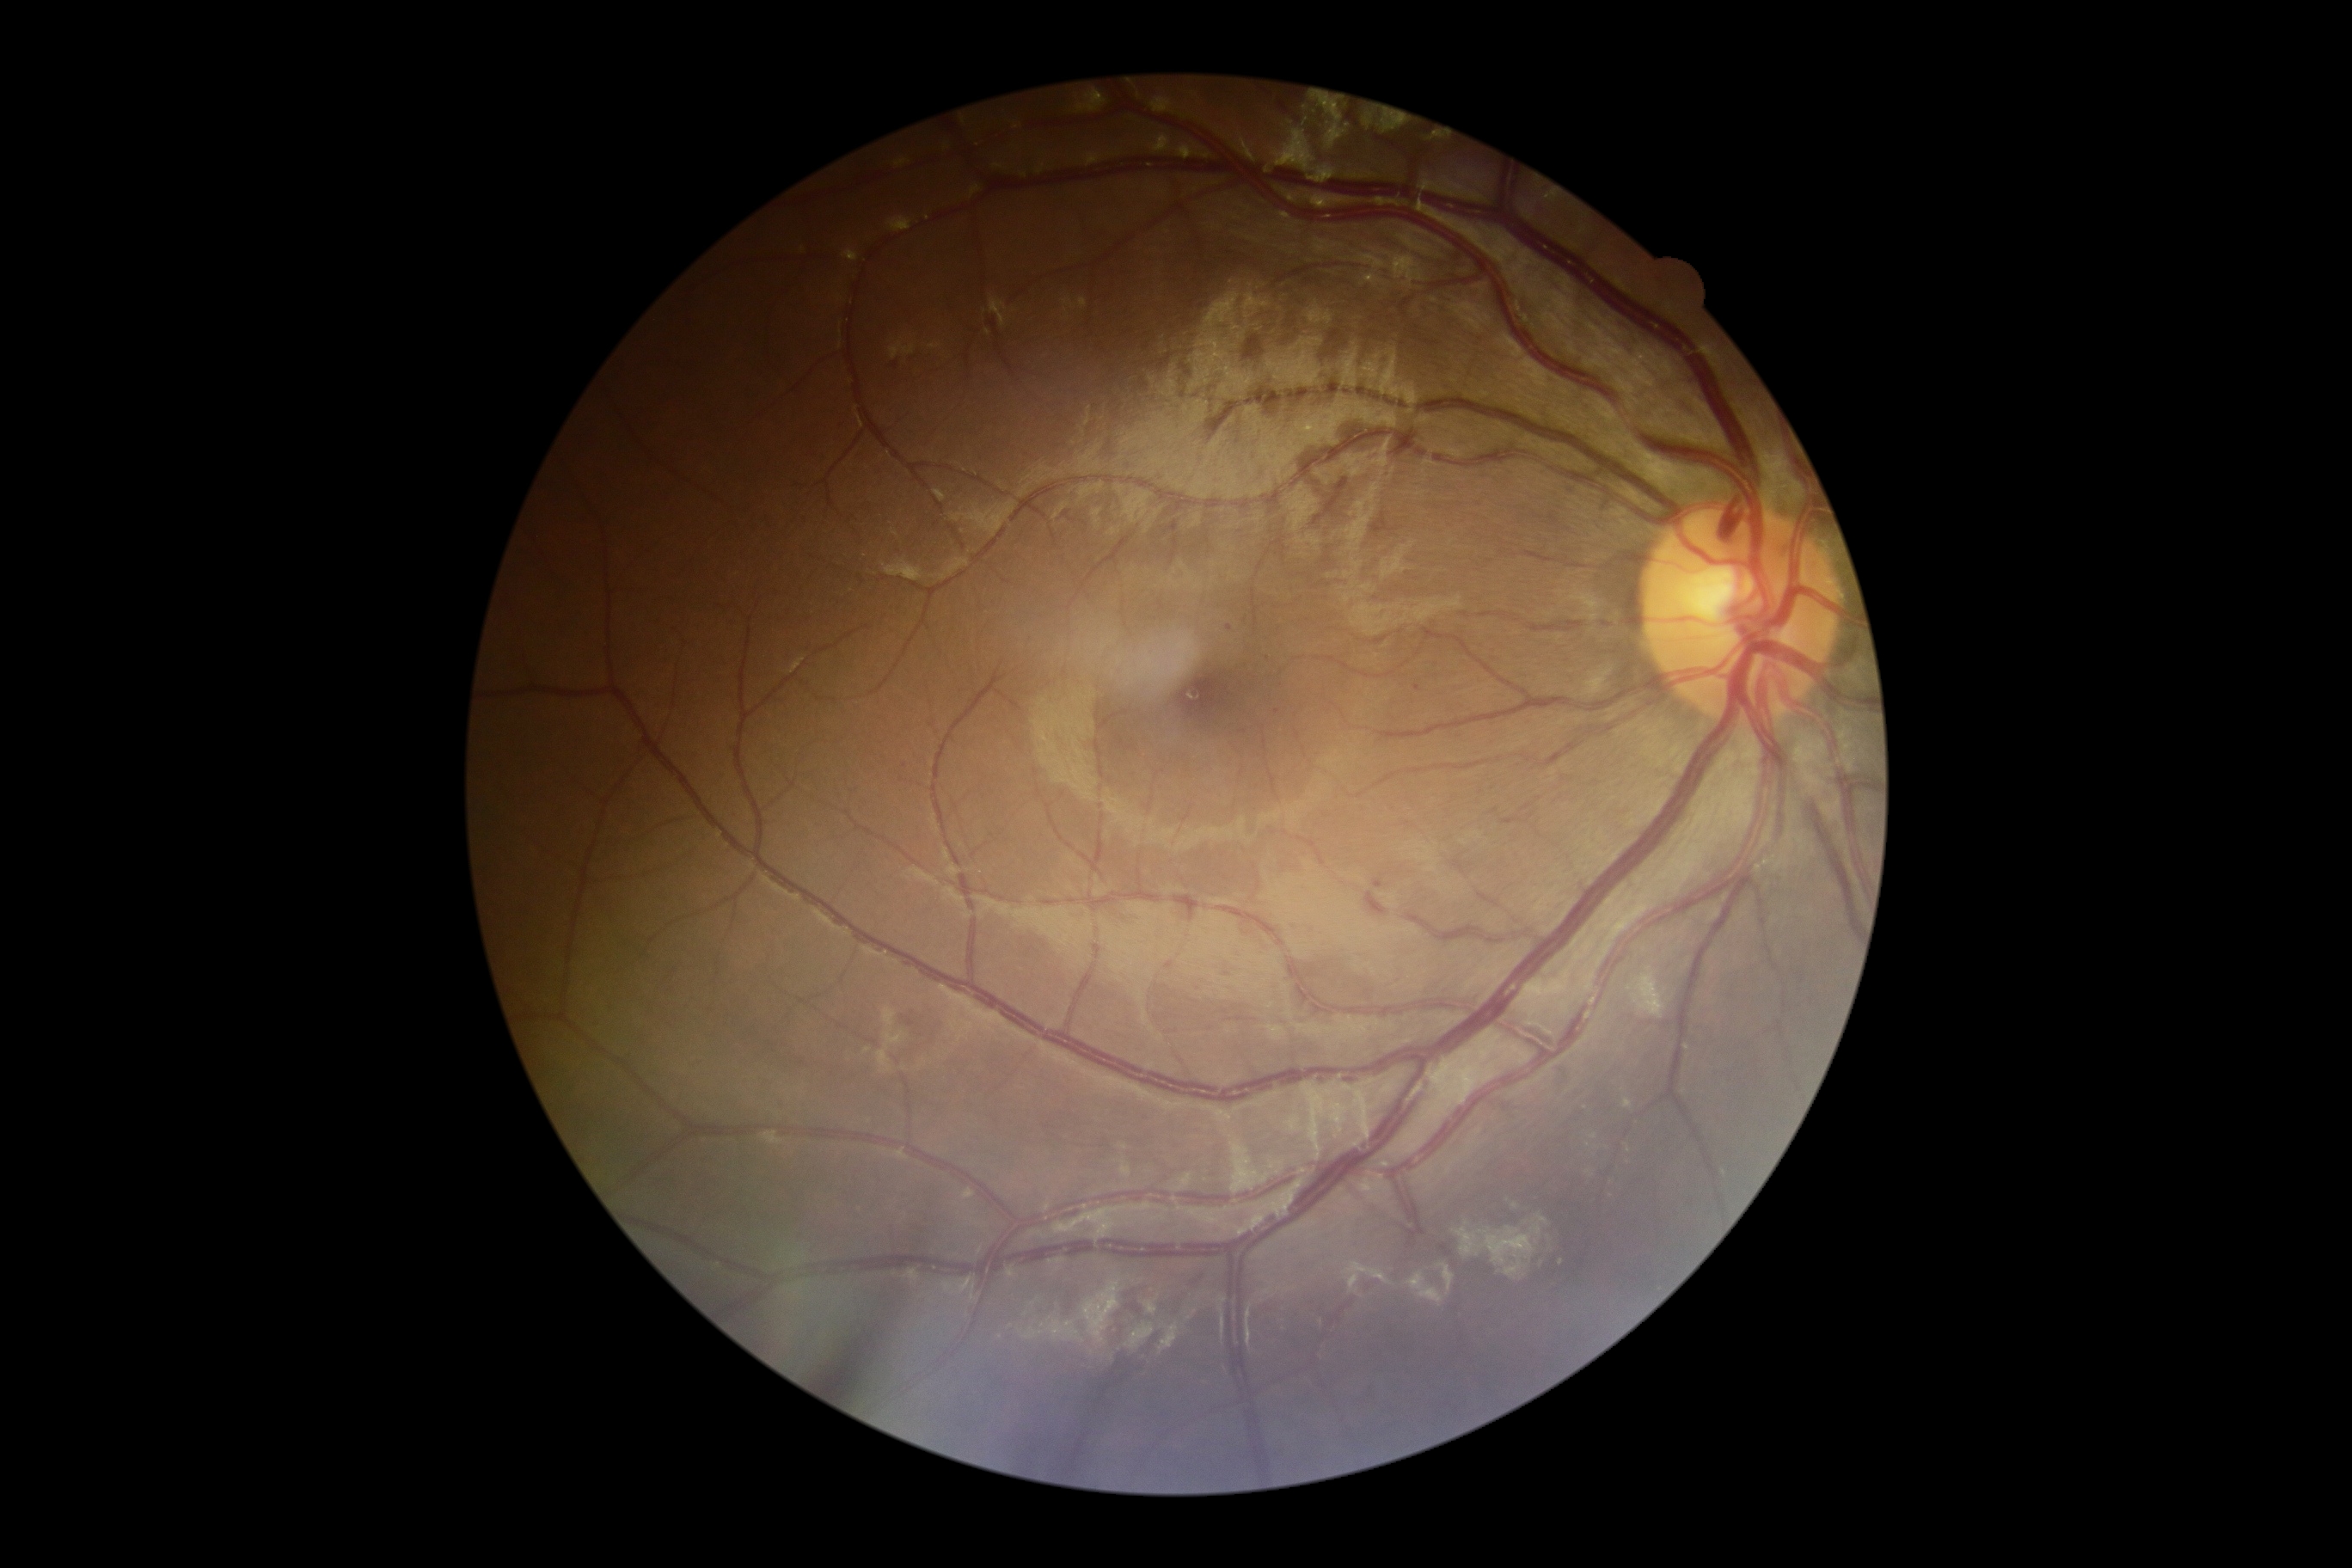

DR severity@mild NPDR (grade 1), DR class@non-proliferative diabetic retinopathy.